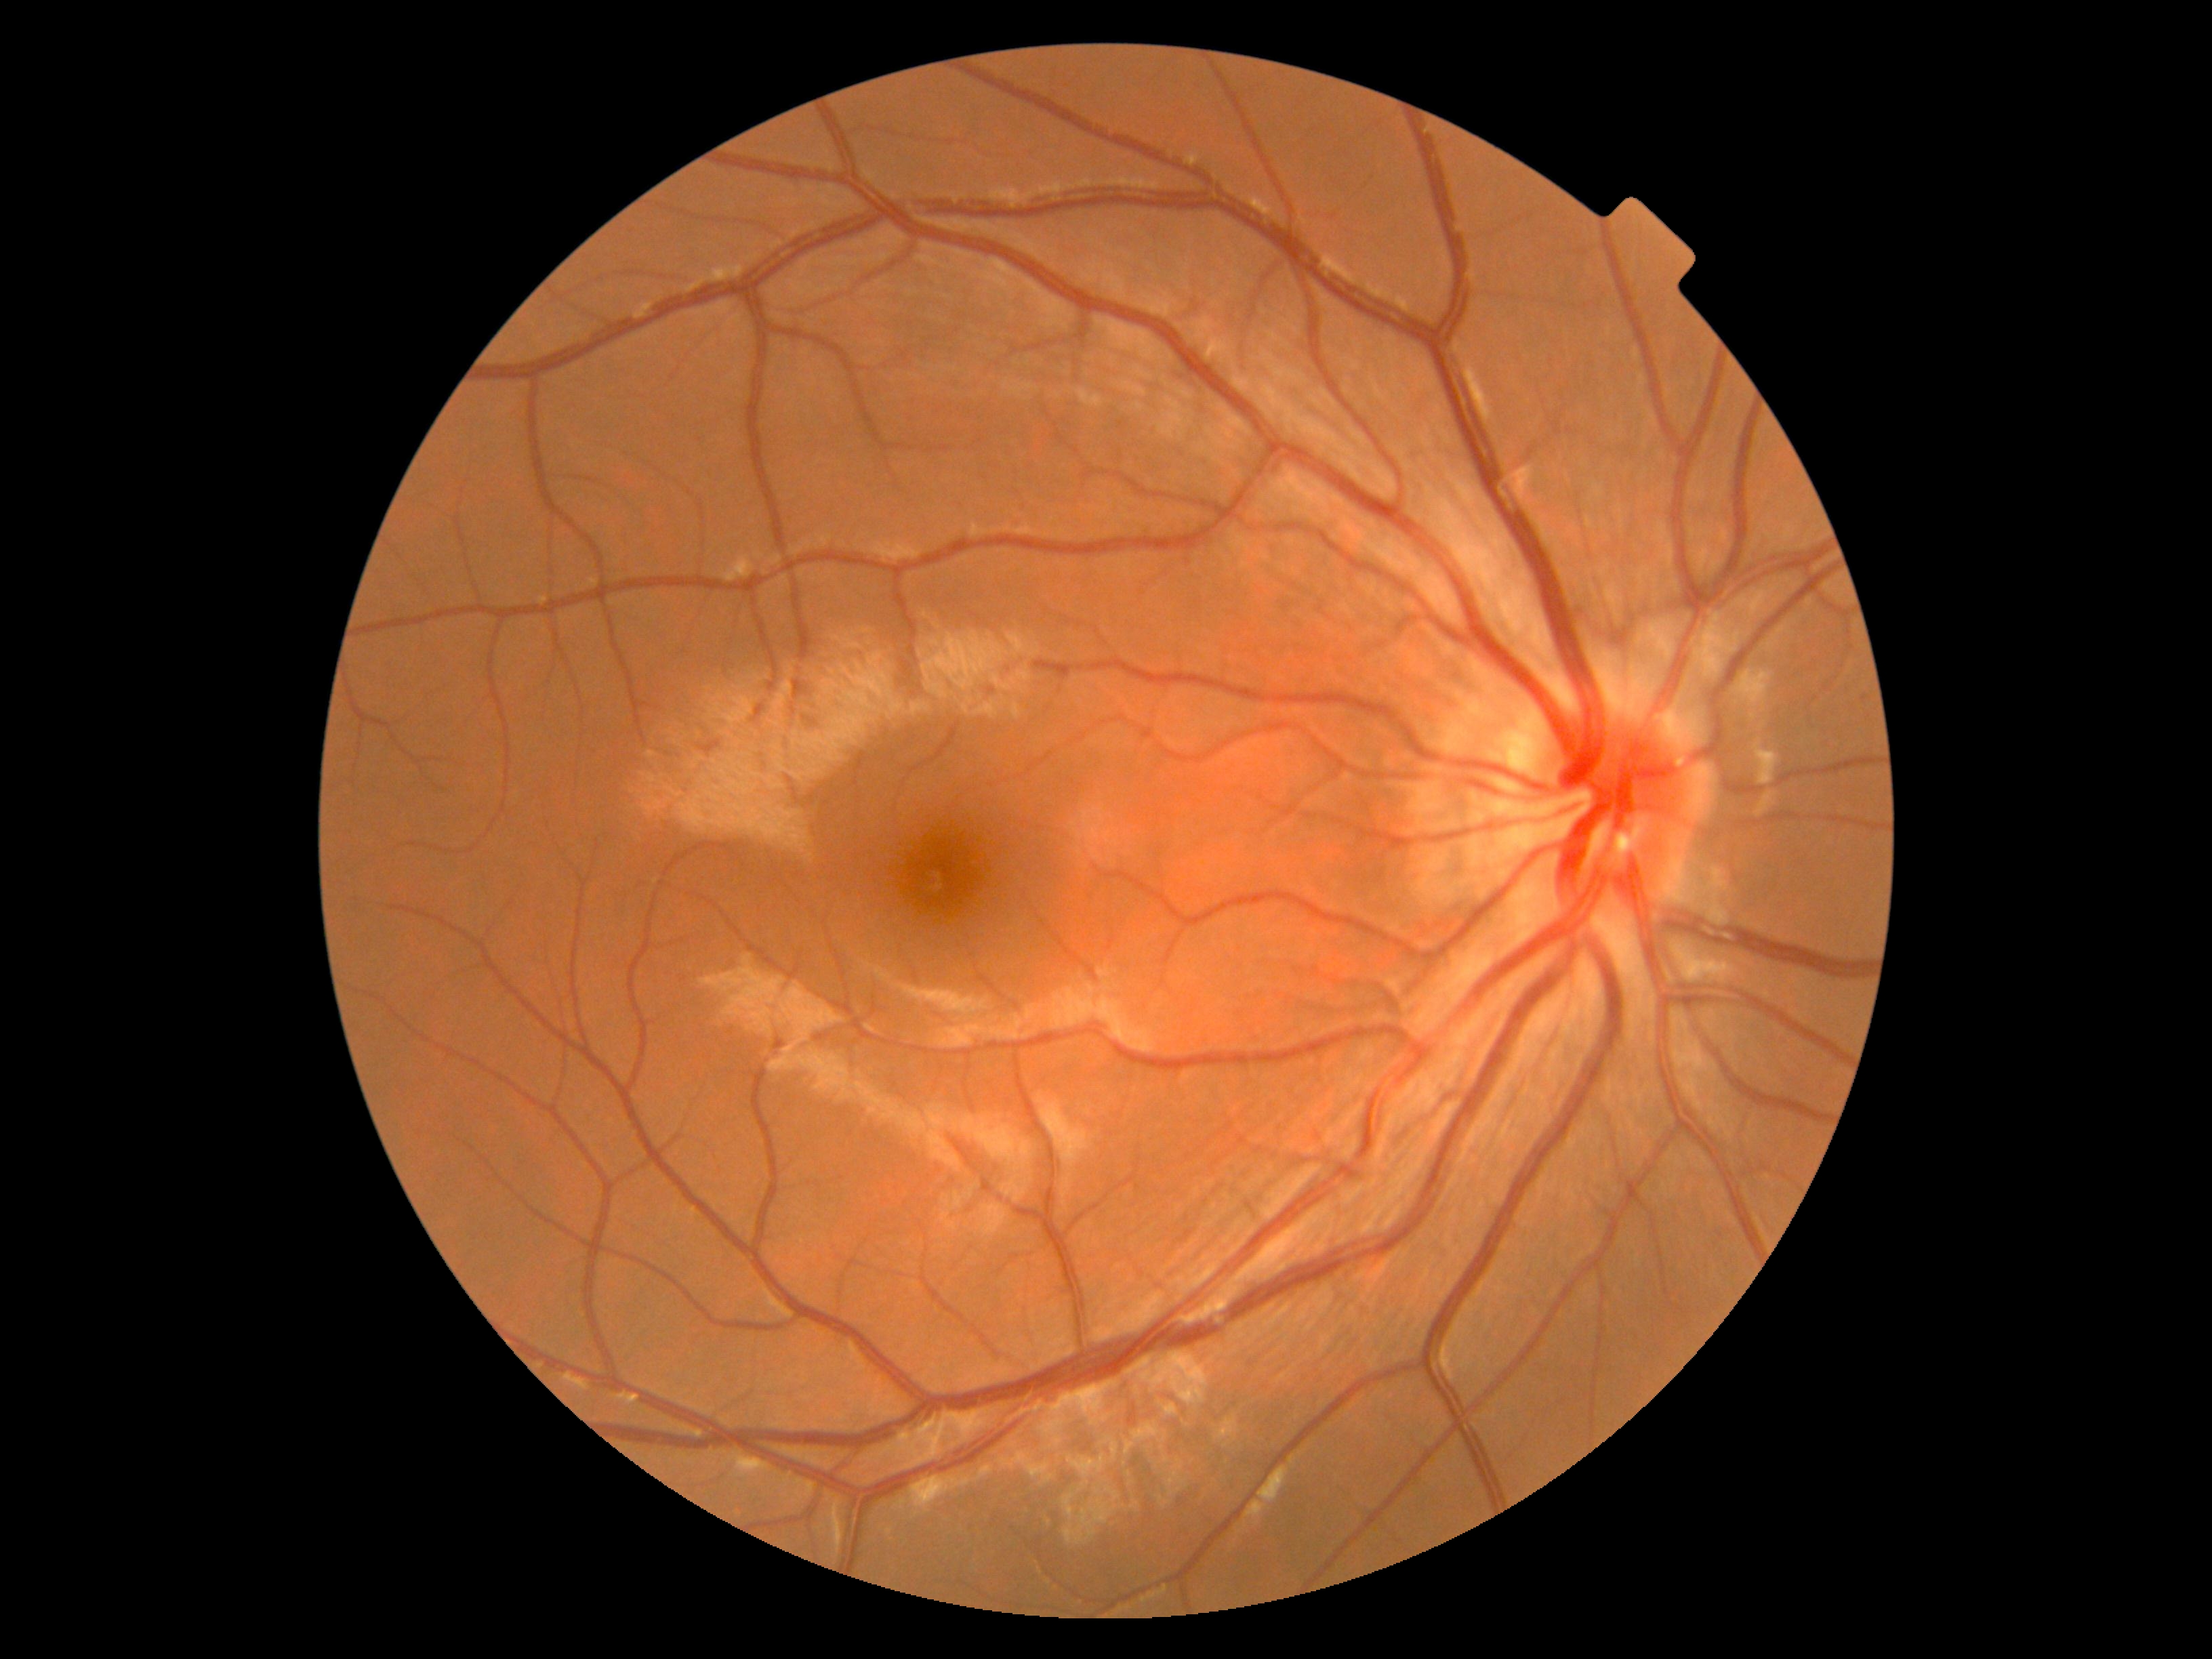
Diabetic retinopathy grade: 0 (no apparent retinopathy).